45° field of view
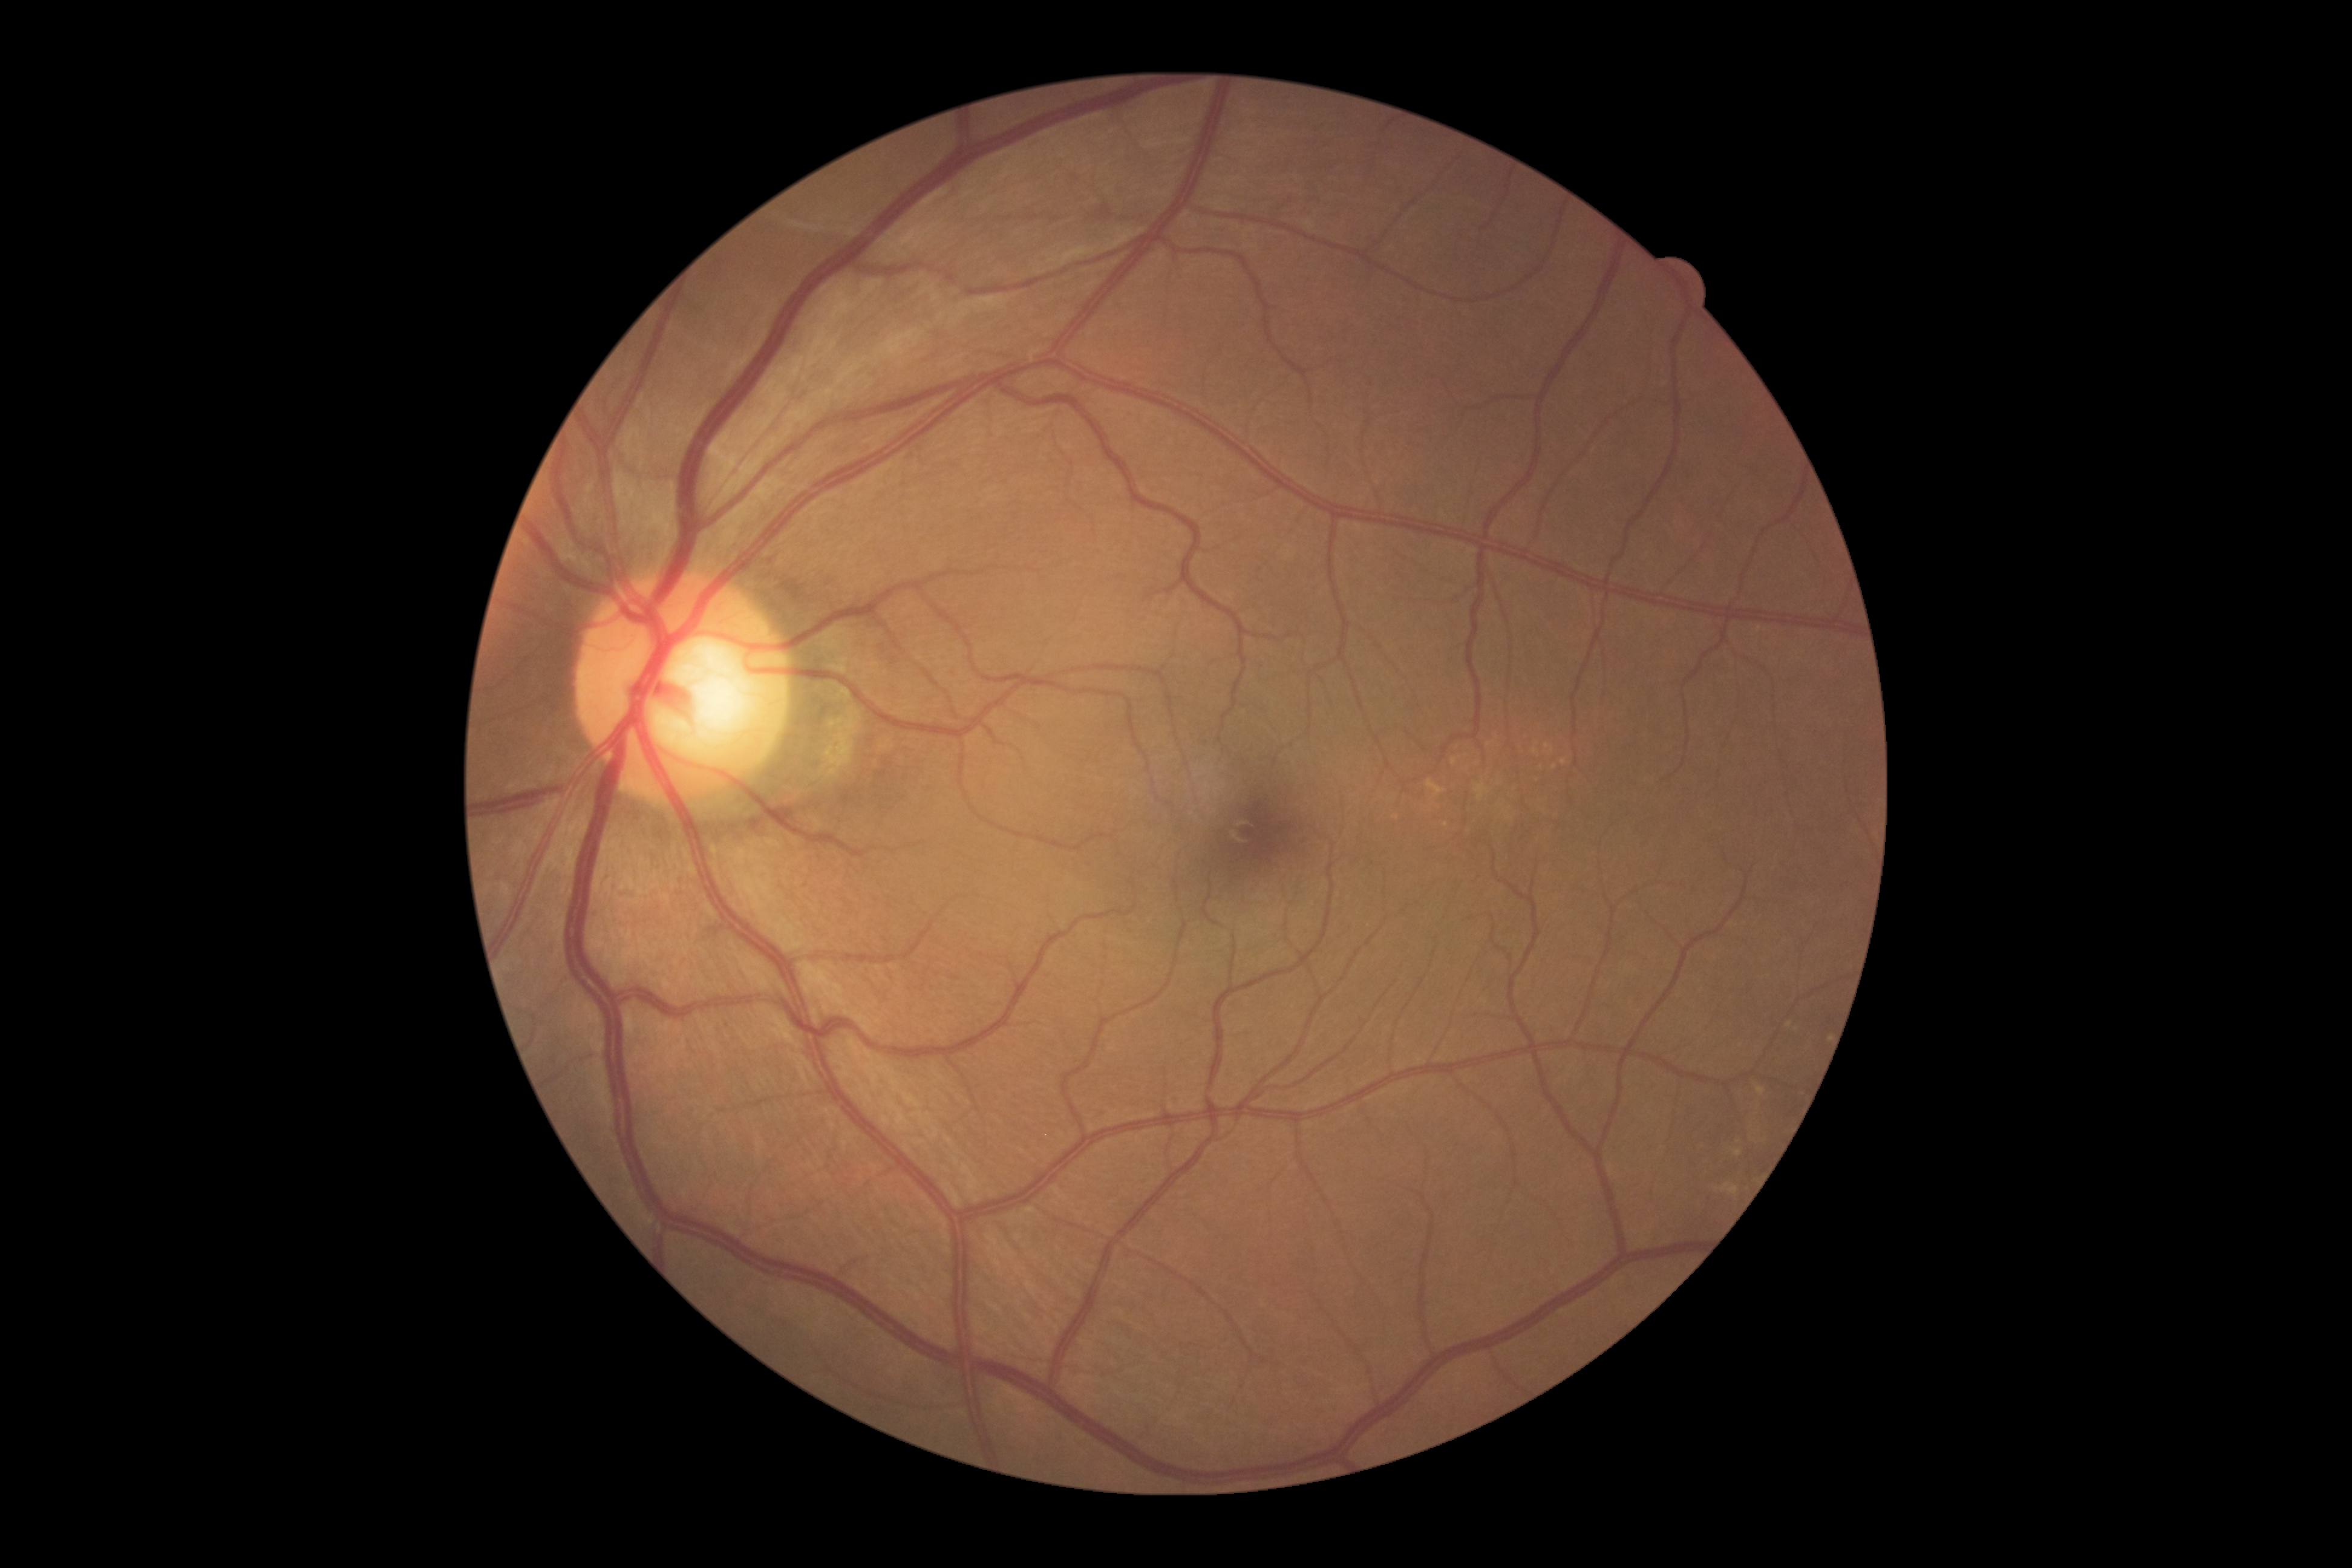

DR severity: grade 0 (no apparent retinopathy).